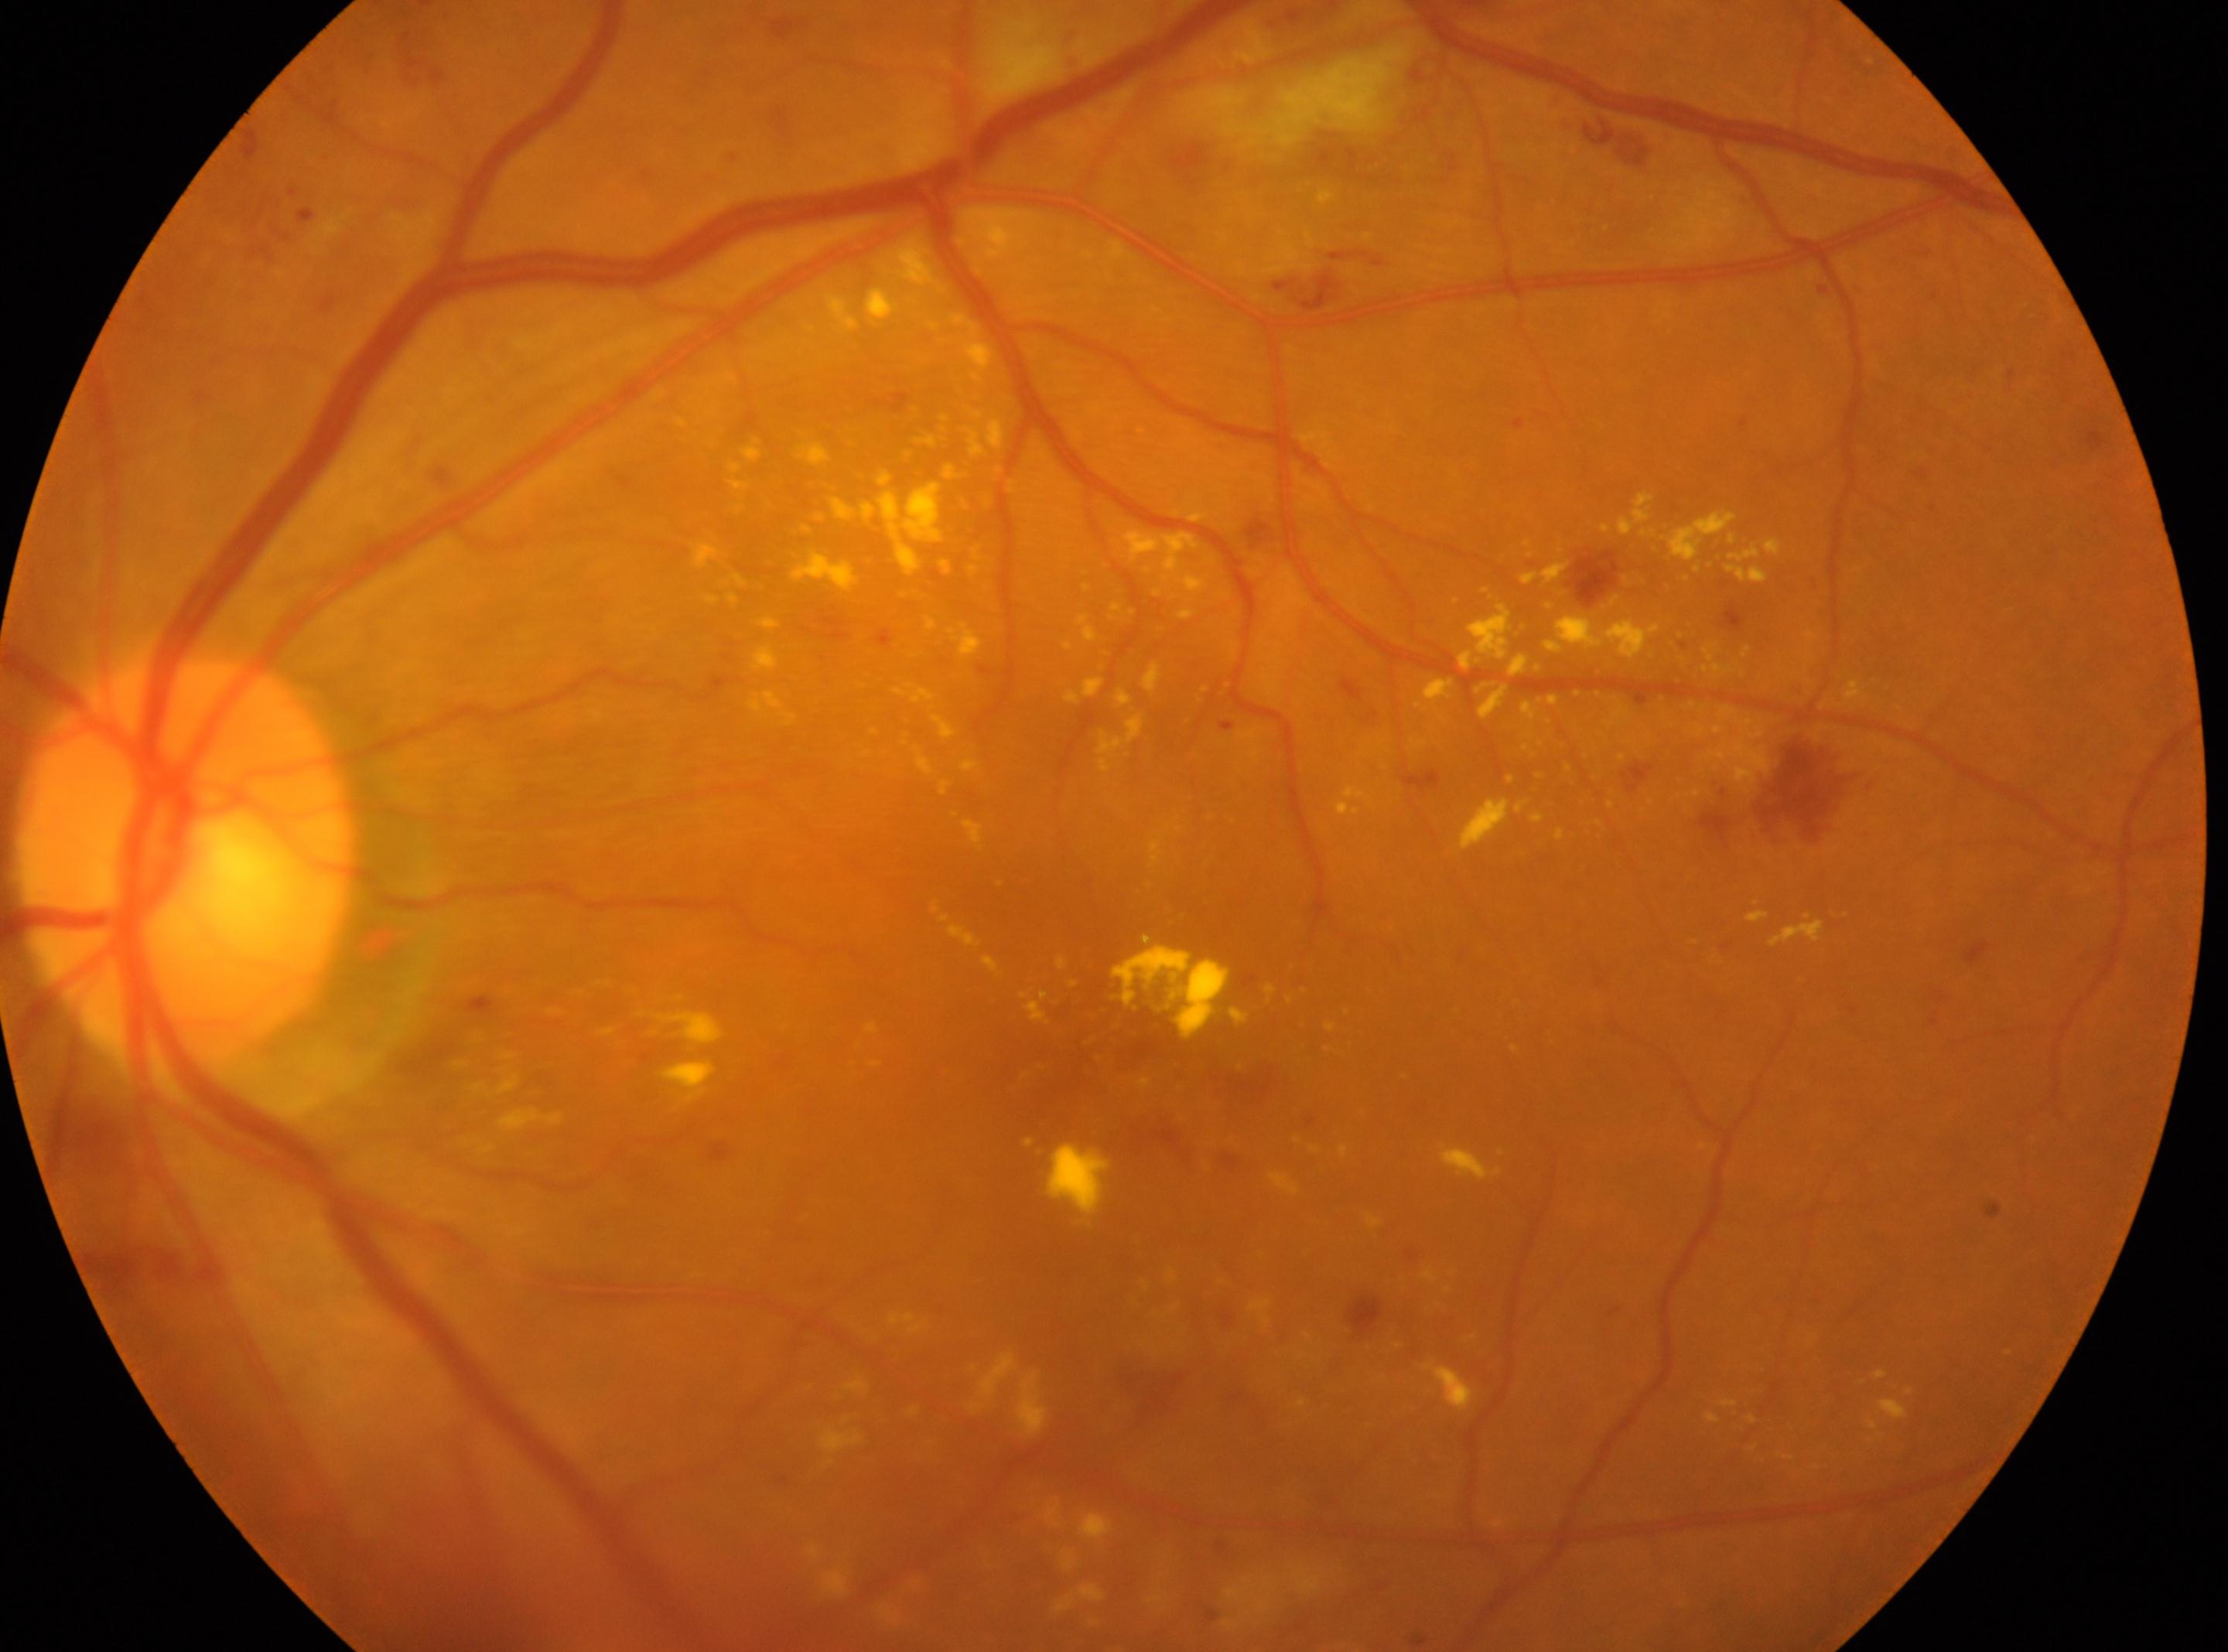 Findings:
* diabetic retinopathy severity · grade 2 (moderate NPDR)
* the fovea · 1126, 1080
* ONH · 184, 859
* laterality · left